Modified Davis classification:
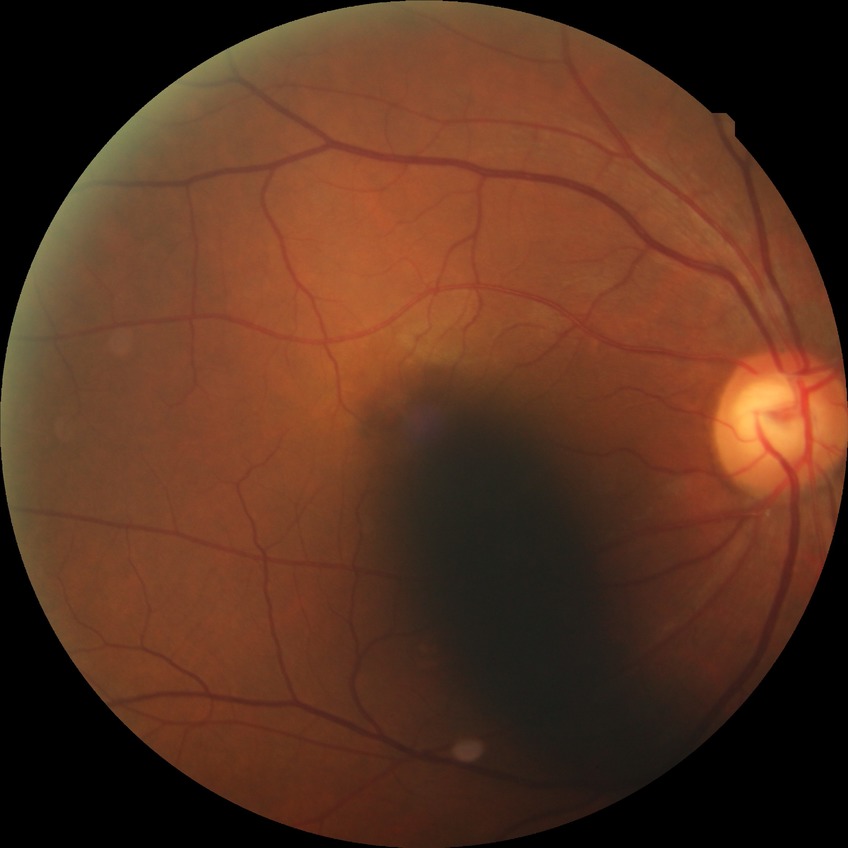

davis_grade: NDR (no diabetic retinopathy)